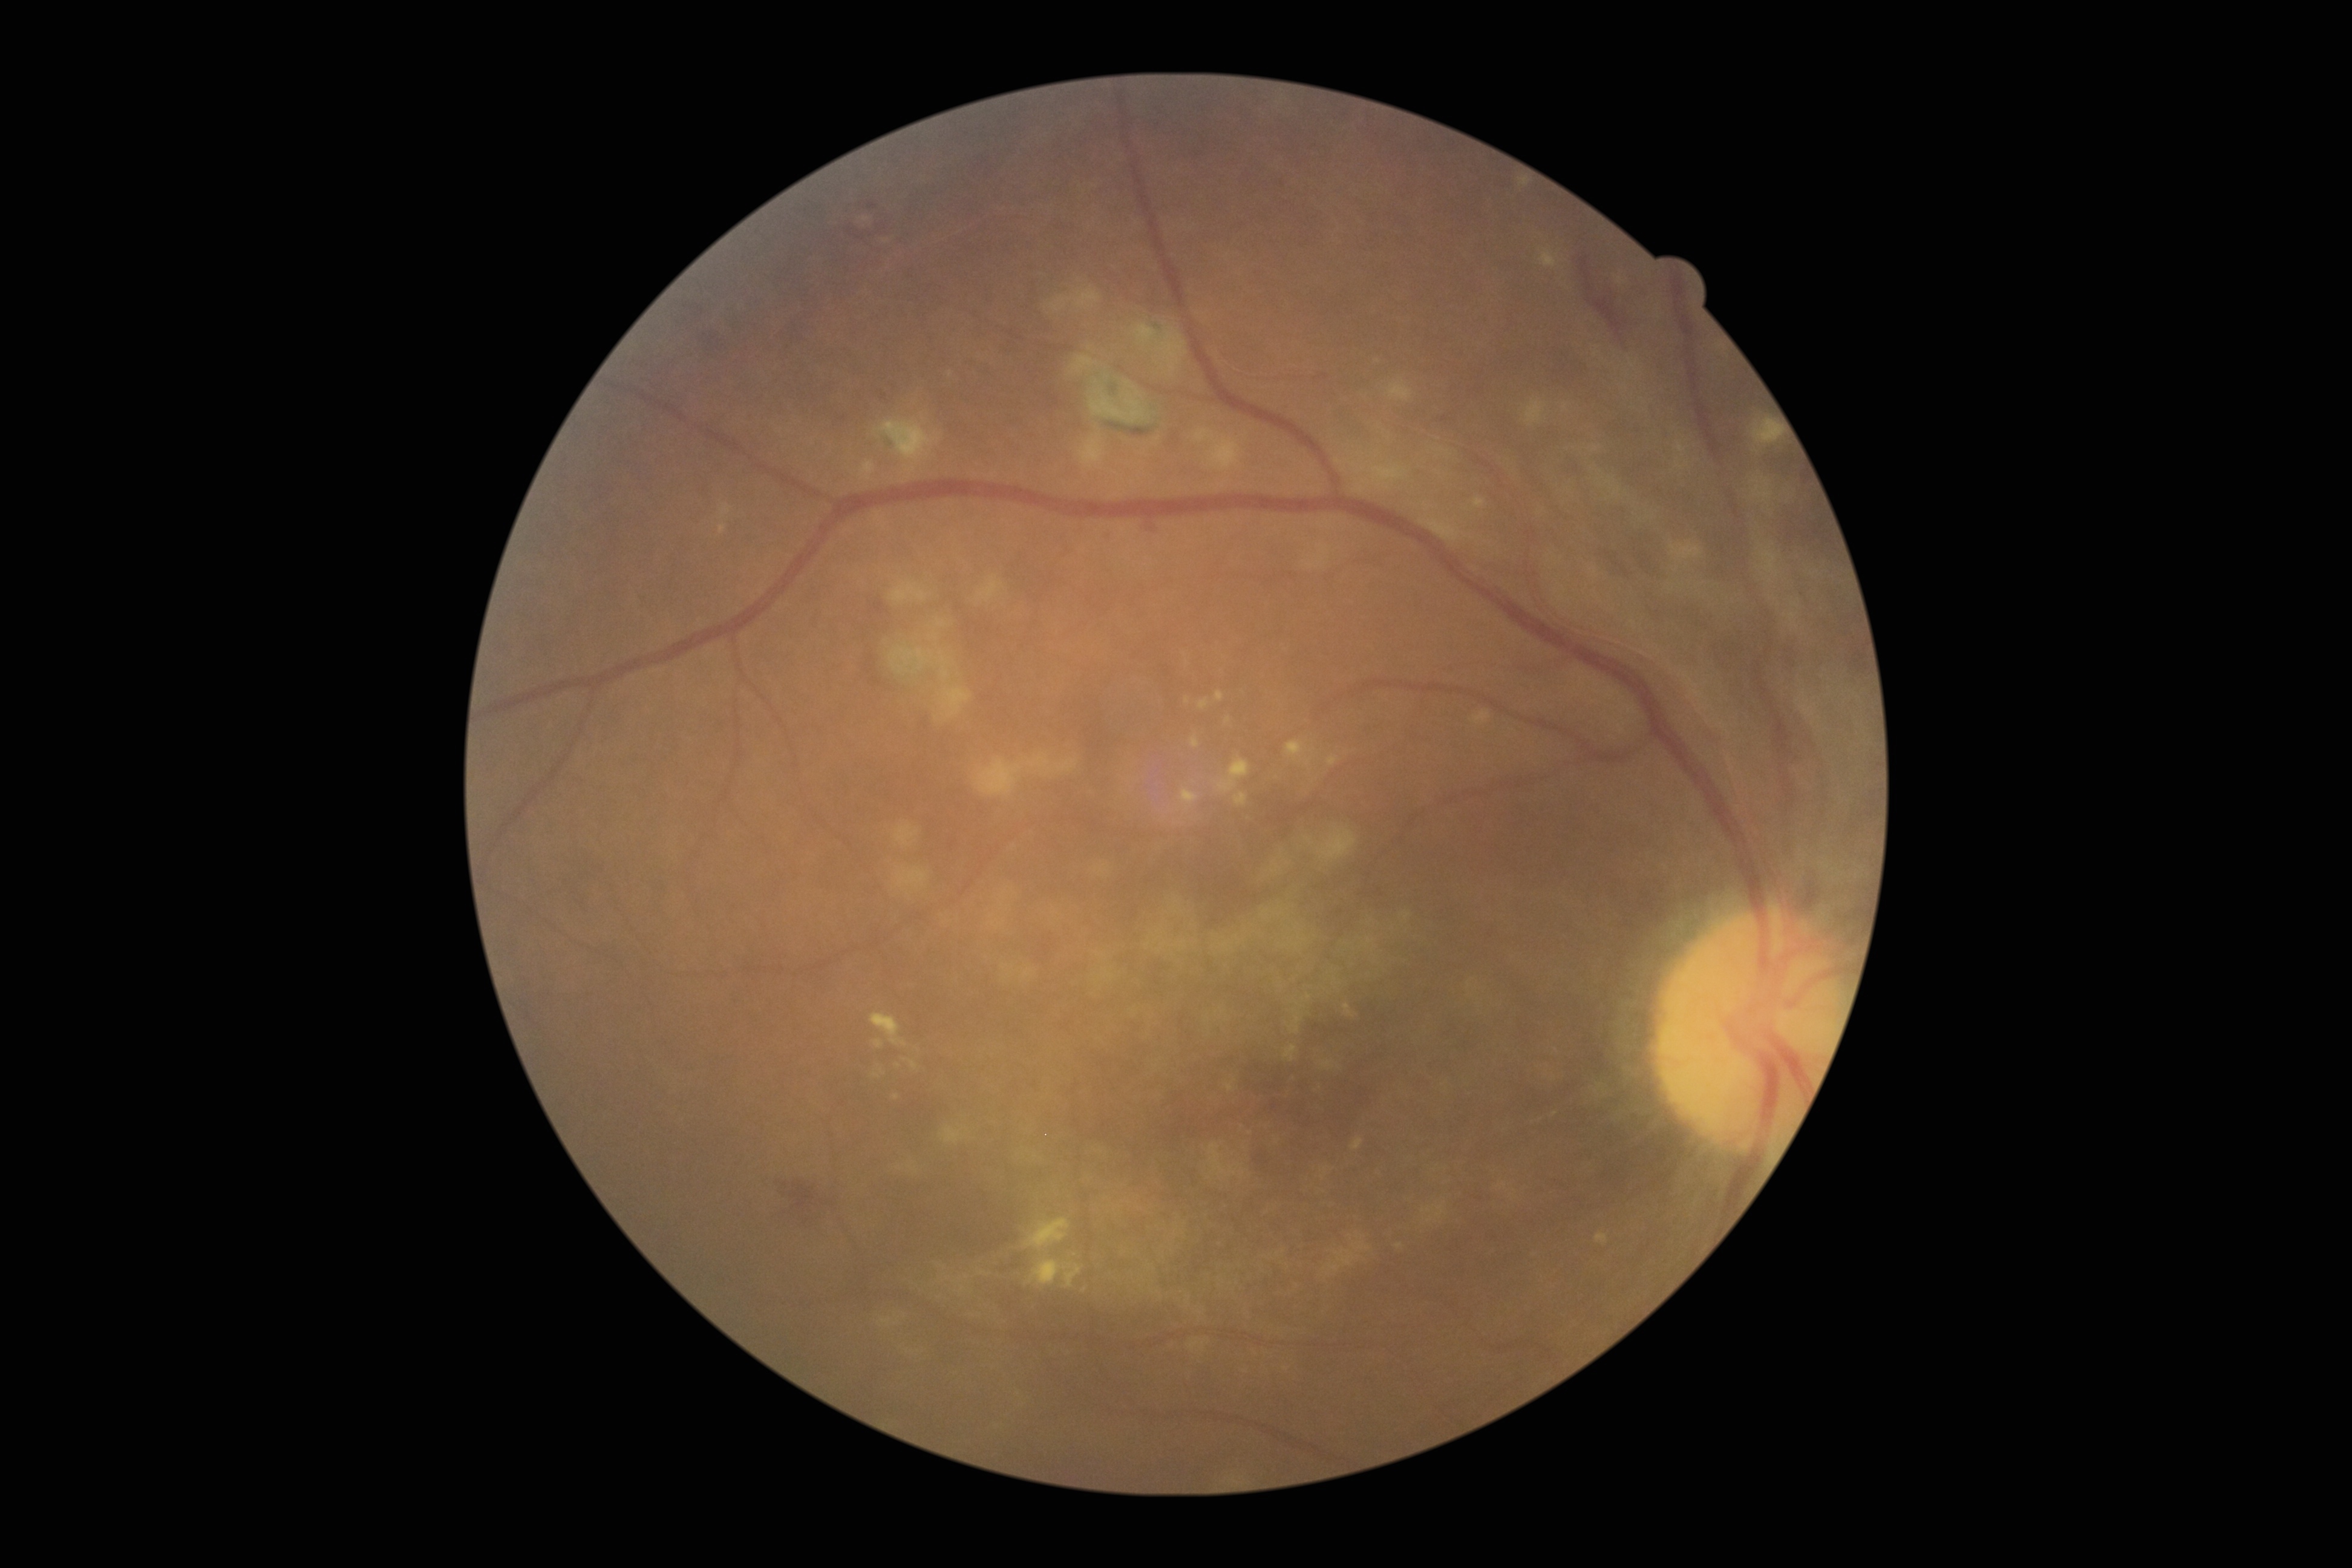 DR is 2/4 — more than just microaneurysms but less than severe NPDR. The retinopathy is classified as non-proliferative diabetic retinopathy.